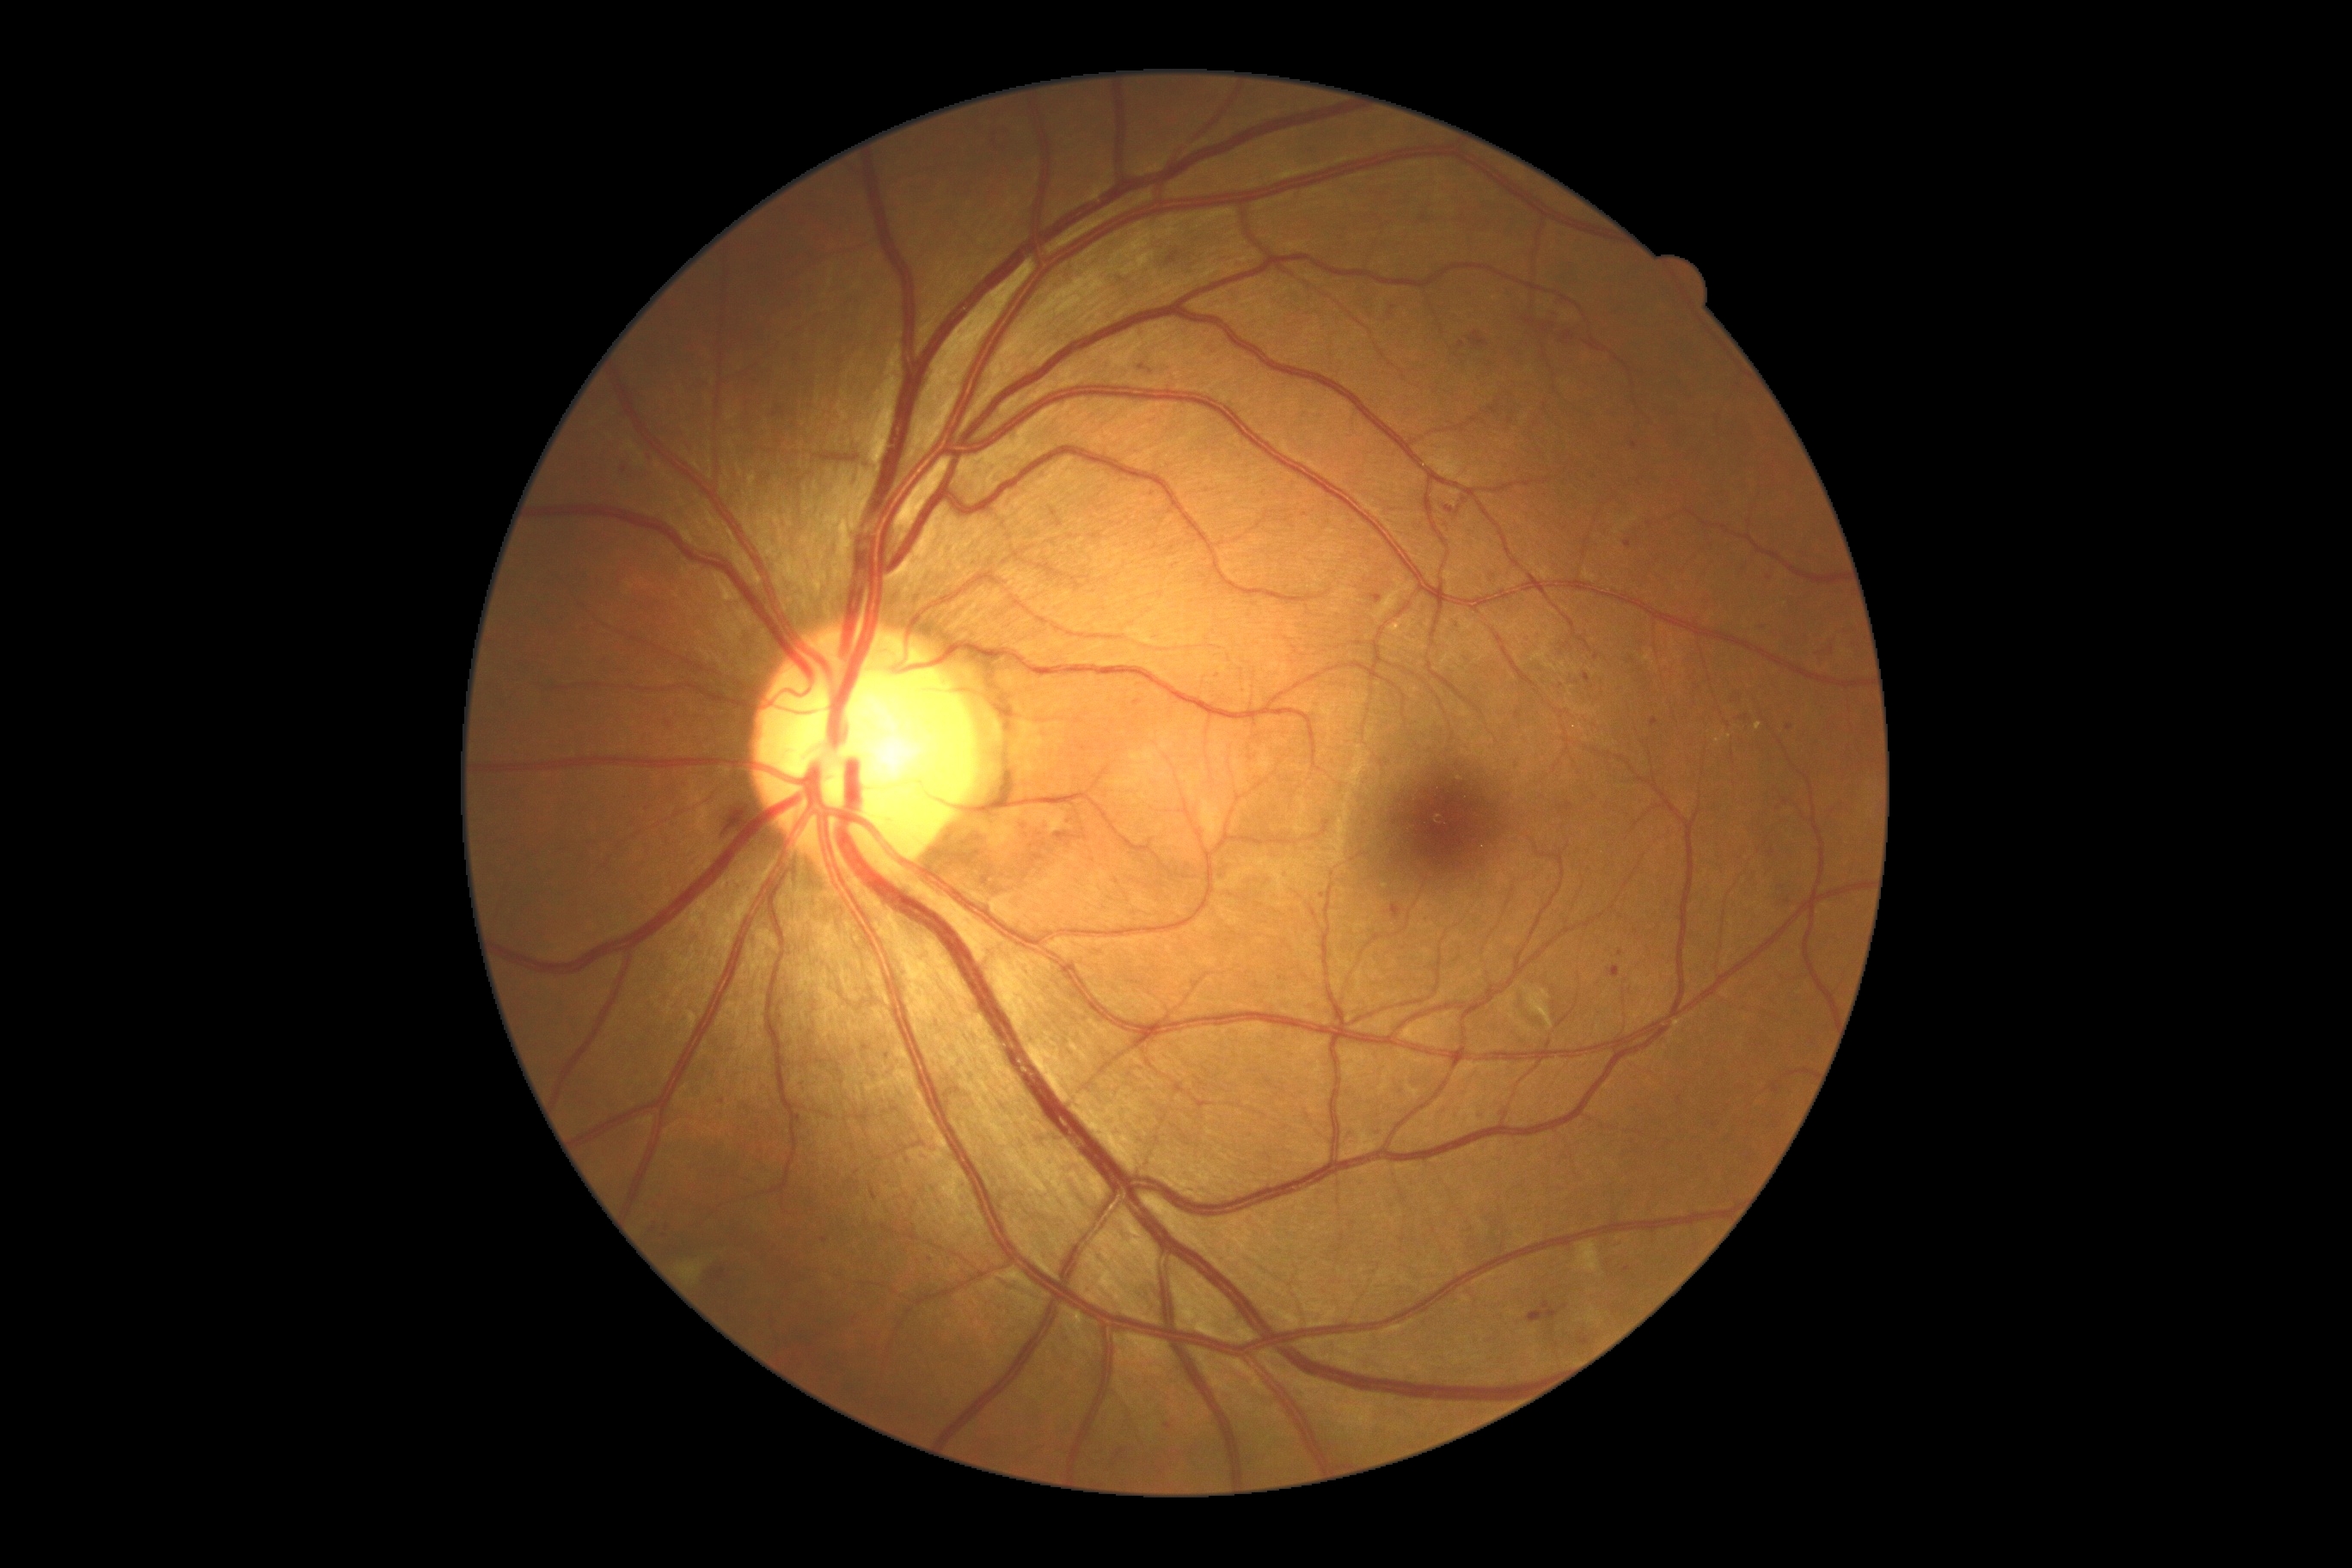

Diabetic retinopathy severity: moderate NPDR (grade 2)
Selected lesions:
microaneurysms (continued): BBox(1528, 1301, 1560, 1323); BBox(1459, 341, 1464, 350); BBox(1390, 905, 1402, 921); BBox(713, 1270, 726, 1280); BBox(1650, 718, 1658, 728); BBox(1624, 1266, 1632, 1273); BBox(1541, 324, 1548, 334); BBox(1524, 319, 1536, 328)
Additional small microaneurysms near 1392, 308; 1832, 651; 1024, 828; 1778, 809; 624, 471; 824, 1241; 1788, 902; 1153, 494
hard exudates: BBox(1755, 723, 1761, 732); BBox(1715, 730, 1732, 744); BBox(1390, 615, 1416, 637)
hemorrhages: BBox(718, 804, 747, 835)
soft exudates: BBox(1577, 1242, 1602, 1273); BBox(677, 1263, 704, 1283); BBox(1524, 988, 1553, 1031)